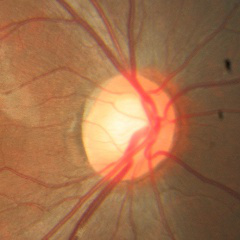
Color fundus photograph showing no signs of glaucoma.